640x480 · captured with the Clarity RetCam 3 (130° field of view) · infant wide-field retinal image
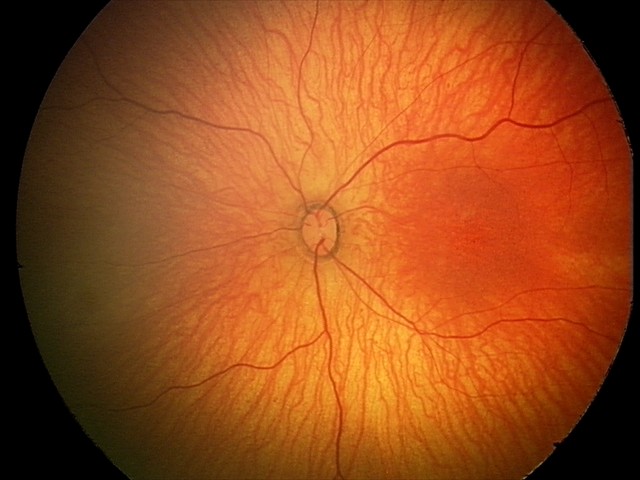
Screening: physiological appearance with no retinal pathology.